Diabetic retinopathy graded by the modified Davis classification · FOV: 45 degrees:
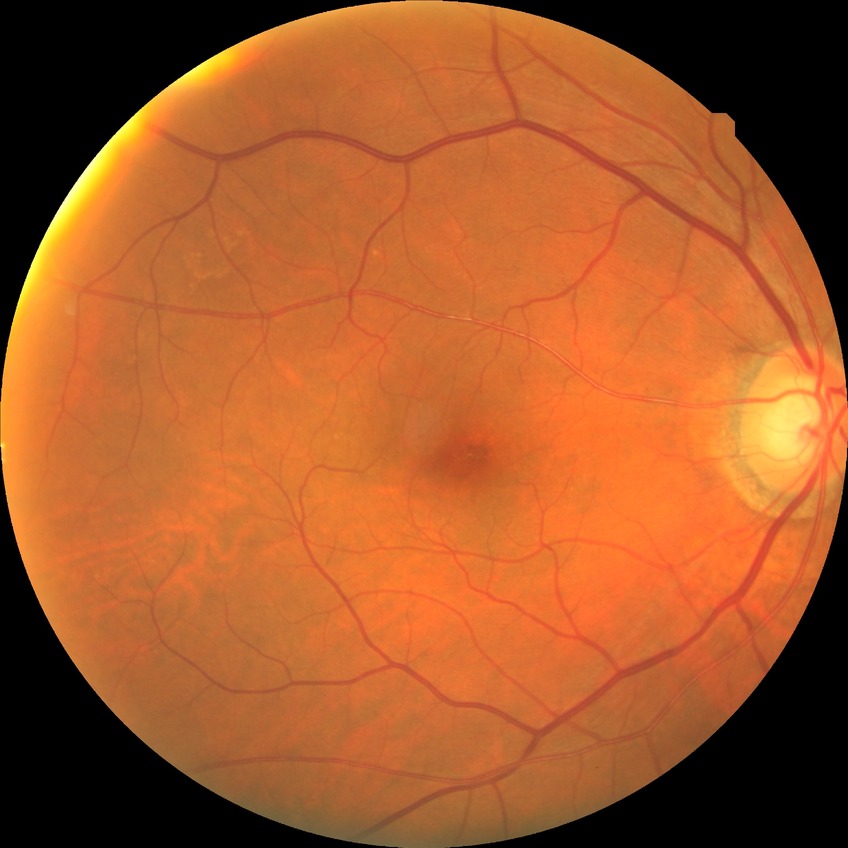 Diabetic retinopathy (DR): NDR (no diabetic retinopathy).